NIDEK AFC-230. Diabetic retinopathy graded by the modified Davis classification — 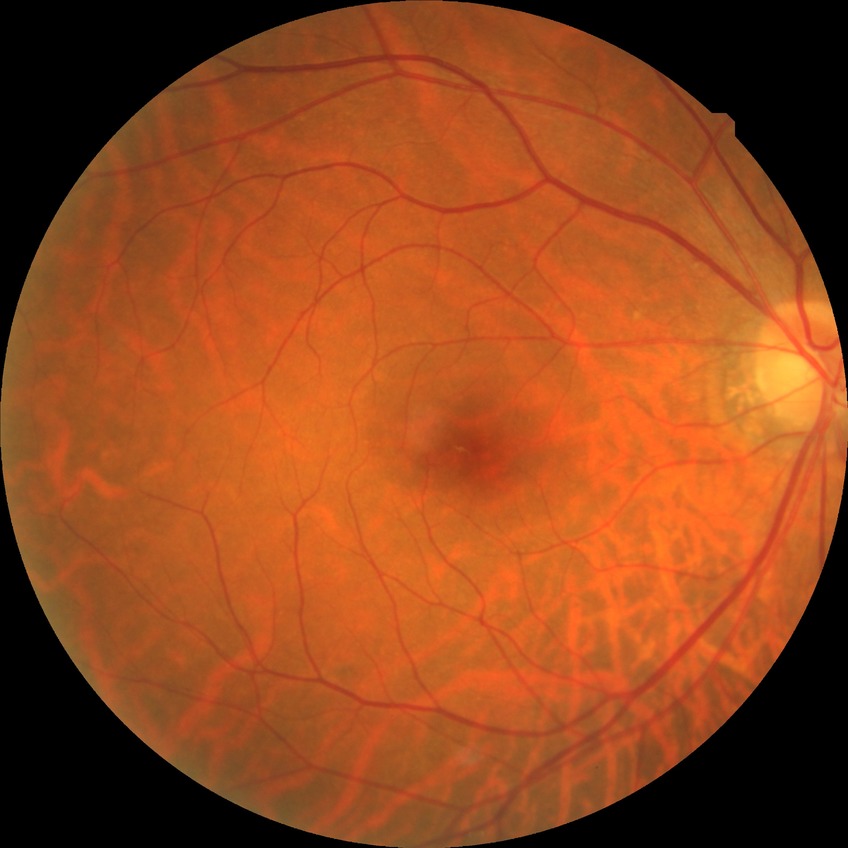

Retinopathy grade: no diabetic retinopathy.